45° field of view — 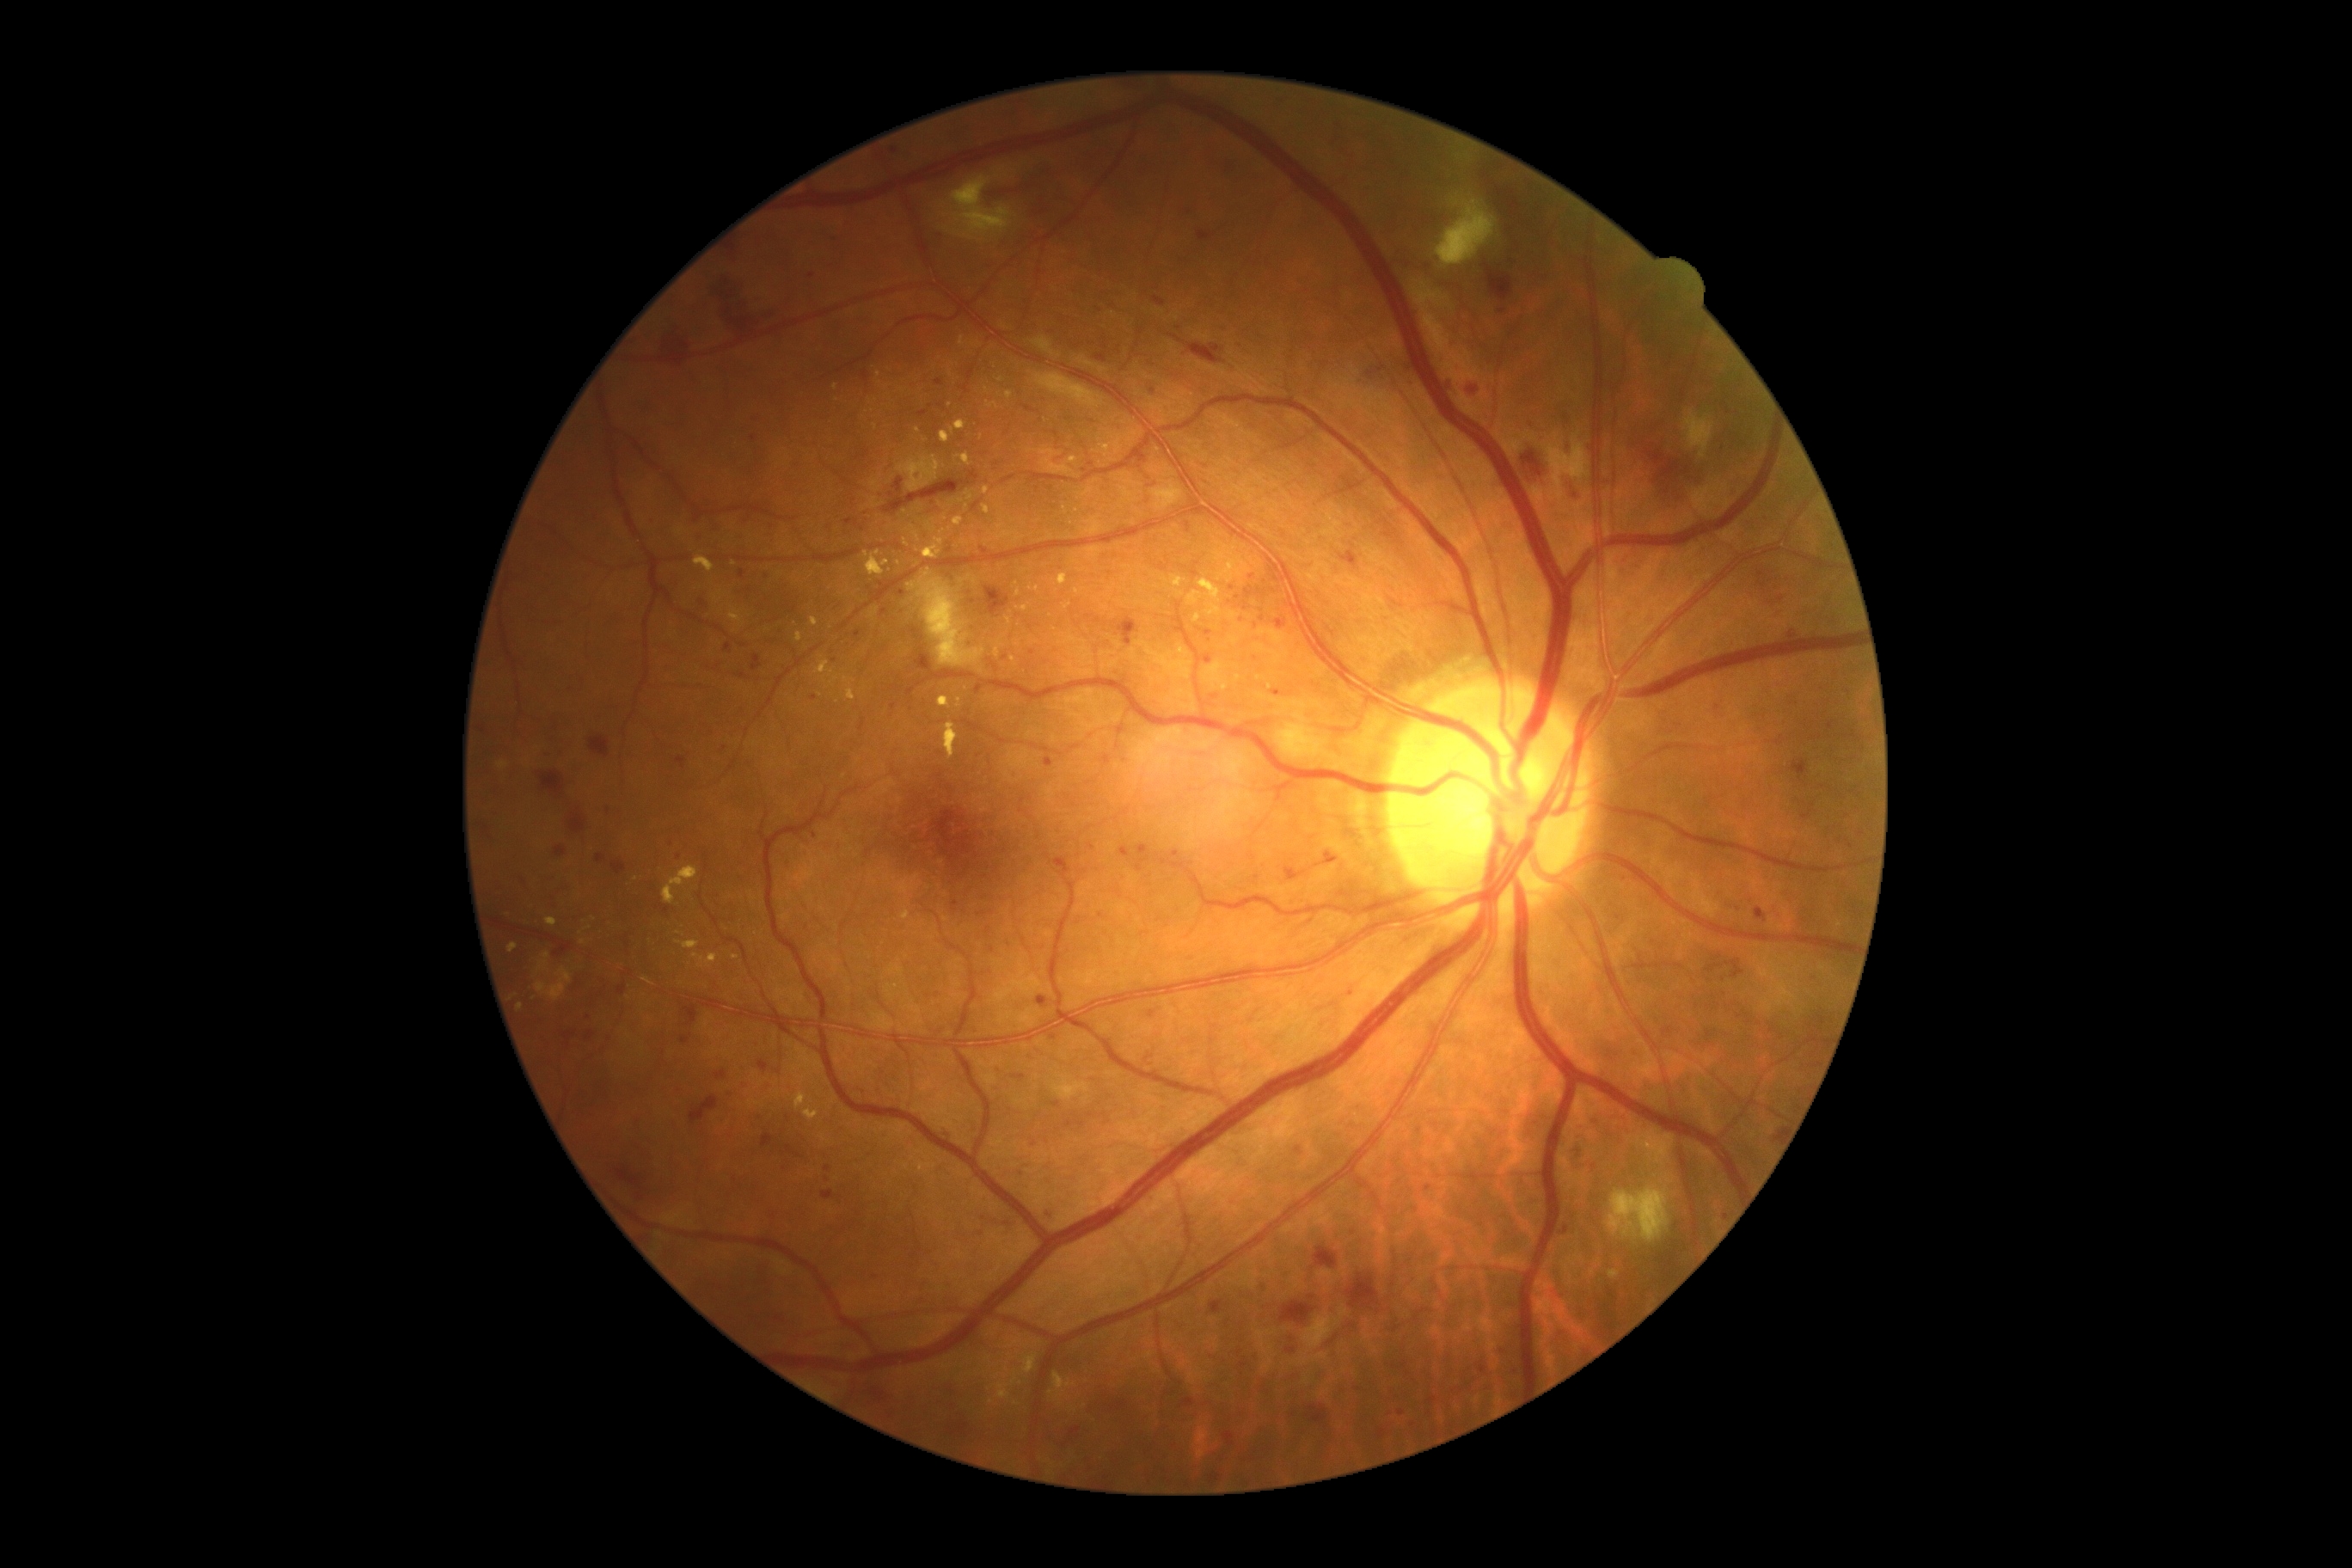
DR grade is 3 — more than 20 intraretinal hemorrhages in each of 4 quadrants, definite venous beading in 2 or more quadrants, or prominent intraretinal microvascular abnormalities in 1 or more quadrants, with no signs of proliferative retinopathy.
HEs (partial list) at [690,1096,718,1124]; [596,855,606,864]; [1792,759,1808,781]; [1069,1428,1082,1440]; [563,1032,572,1041]; [1564,1227,1569,1235]; [1562,422,1572,458]; [1258,1282,1271,1292]; [1648,434,1701,499]; [1118,618,1137,647]; [1755,909,1768,924]; [1340,551,1357,568]; [1275,620,1287,630]; [587,1032,594,1041]; [893,479,903,494]; [1485,266,1514,302]; [618,984,627,996].
EXs (partial list) at [1058,573,1069,587]; [537,953,549,974]; [965,493,972,501]; [677,941,701,950]; [957,697,962,709]; [864,551,890,575]; [1017,589,1020,597]; [926,522,936,532]; [1010,1371,1022,1385]; [1194,615,1201,623]; [1069,456,1077,465]; [922,537,943,560].
Additional small EXs near point(879, 374); point(588, 928); point(836, 387); point(1030, 589); point(1007, 1371); point(876, 427); point(1009, 621).
MAs (partial list) at [1536,434,1545,443]; [943,1129,950,1137]; [752,654,761,661]; [1287,869,1295,879].
Additional small MAs near point(668, 839); point(1238, 597); point(1531, 424); point(1054, 1037); point(1000, 1071); point(1049, 1213); point(1208, 634); point(828, 1180); point(815, 835); point(993, 950); point(702, 603); point(858, 635).